Captured with the Natus RetCam Envision (130° field of view). Wide-field fundus image from infant ROP screening.
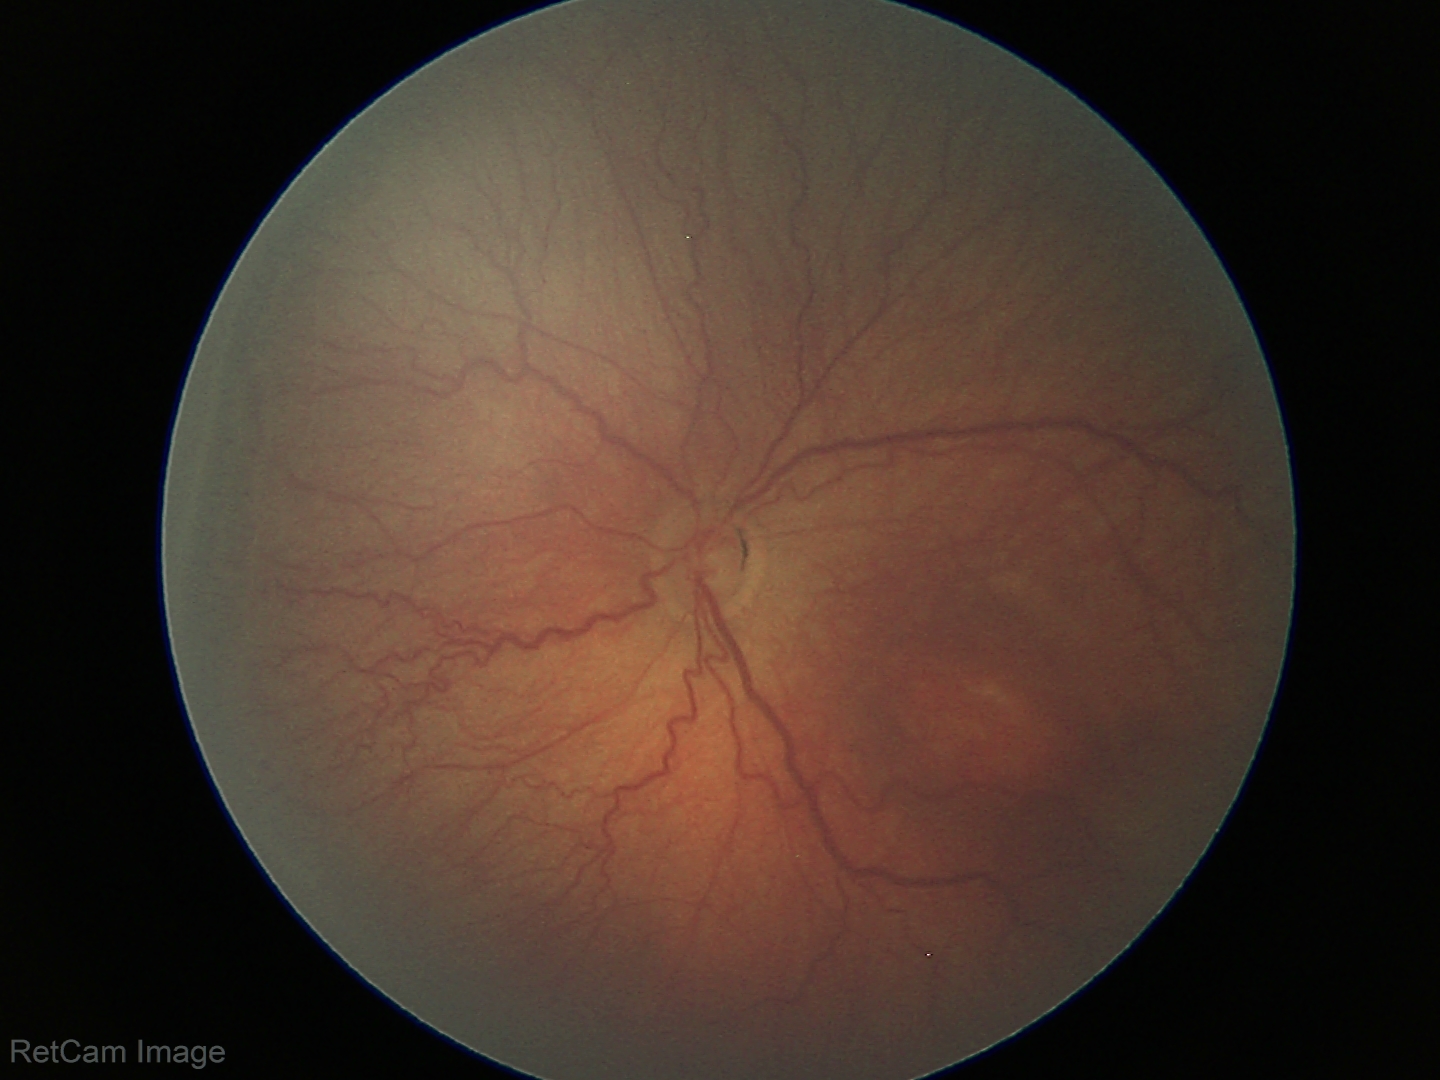
Plus disease absent. Screening series with retinopathy of prematurity (ROP) stage 3.